Wide-field contact fundus photograph of an infant; 1440 by 1080 pixels; acquired on the Natus RetCam Envision
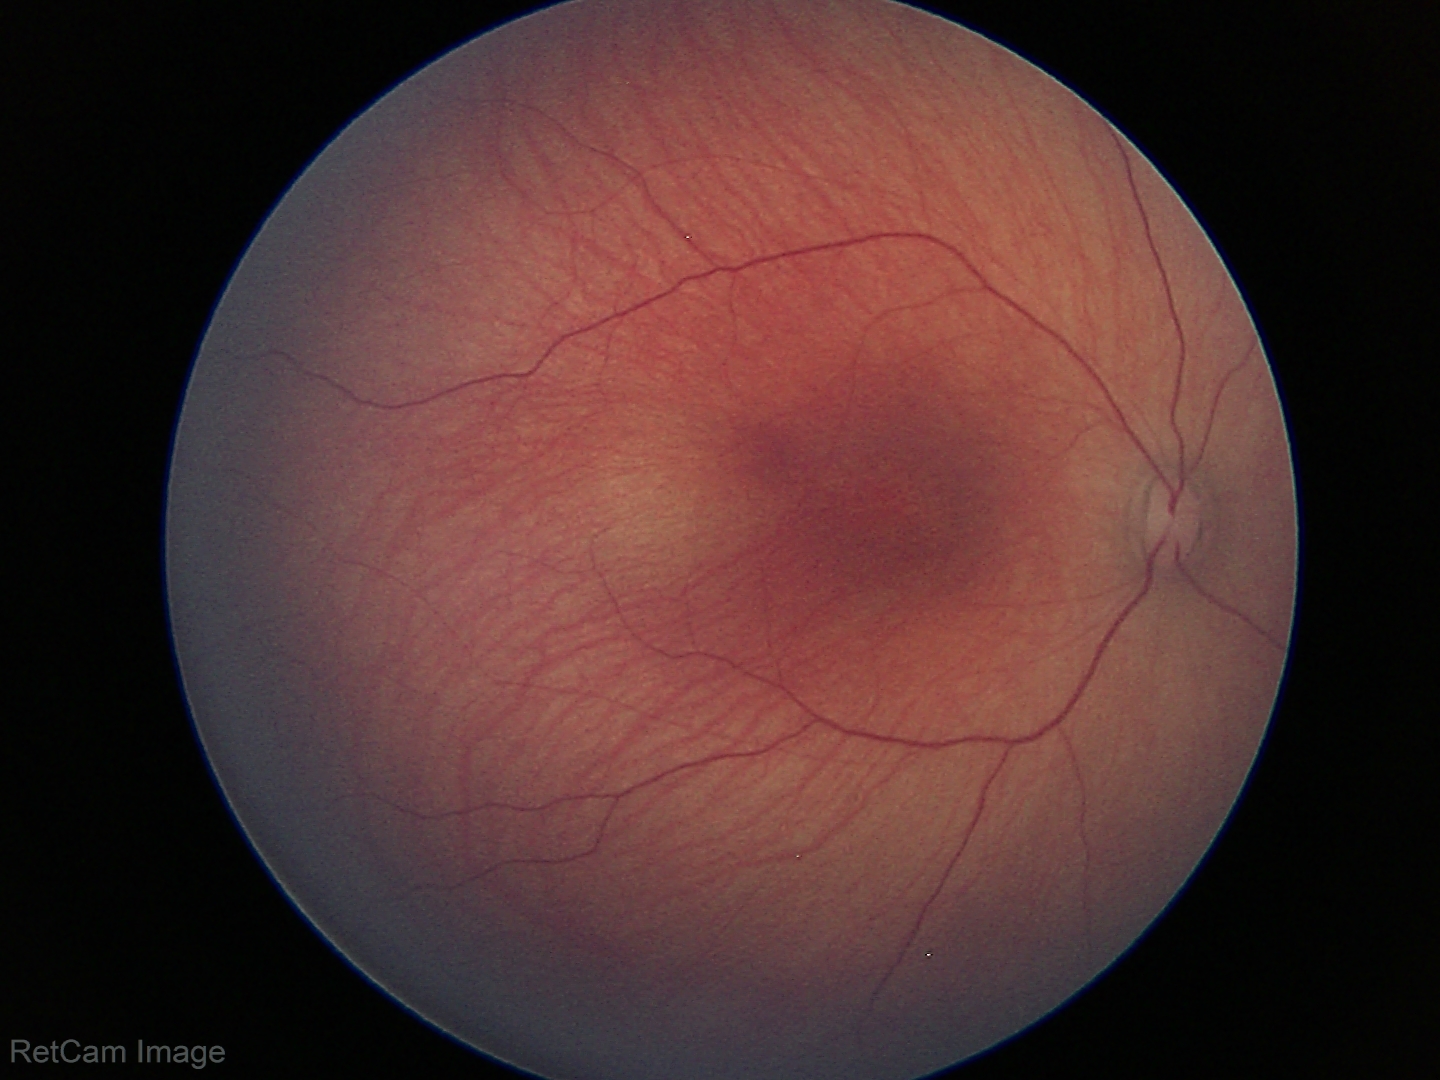 Screening diagnosis = physiological